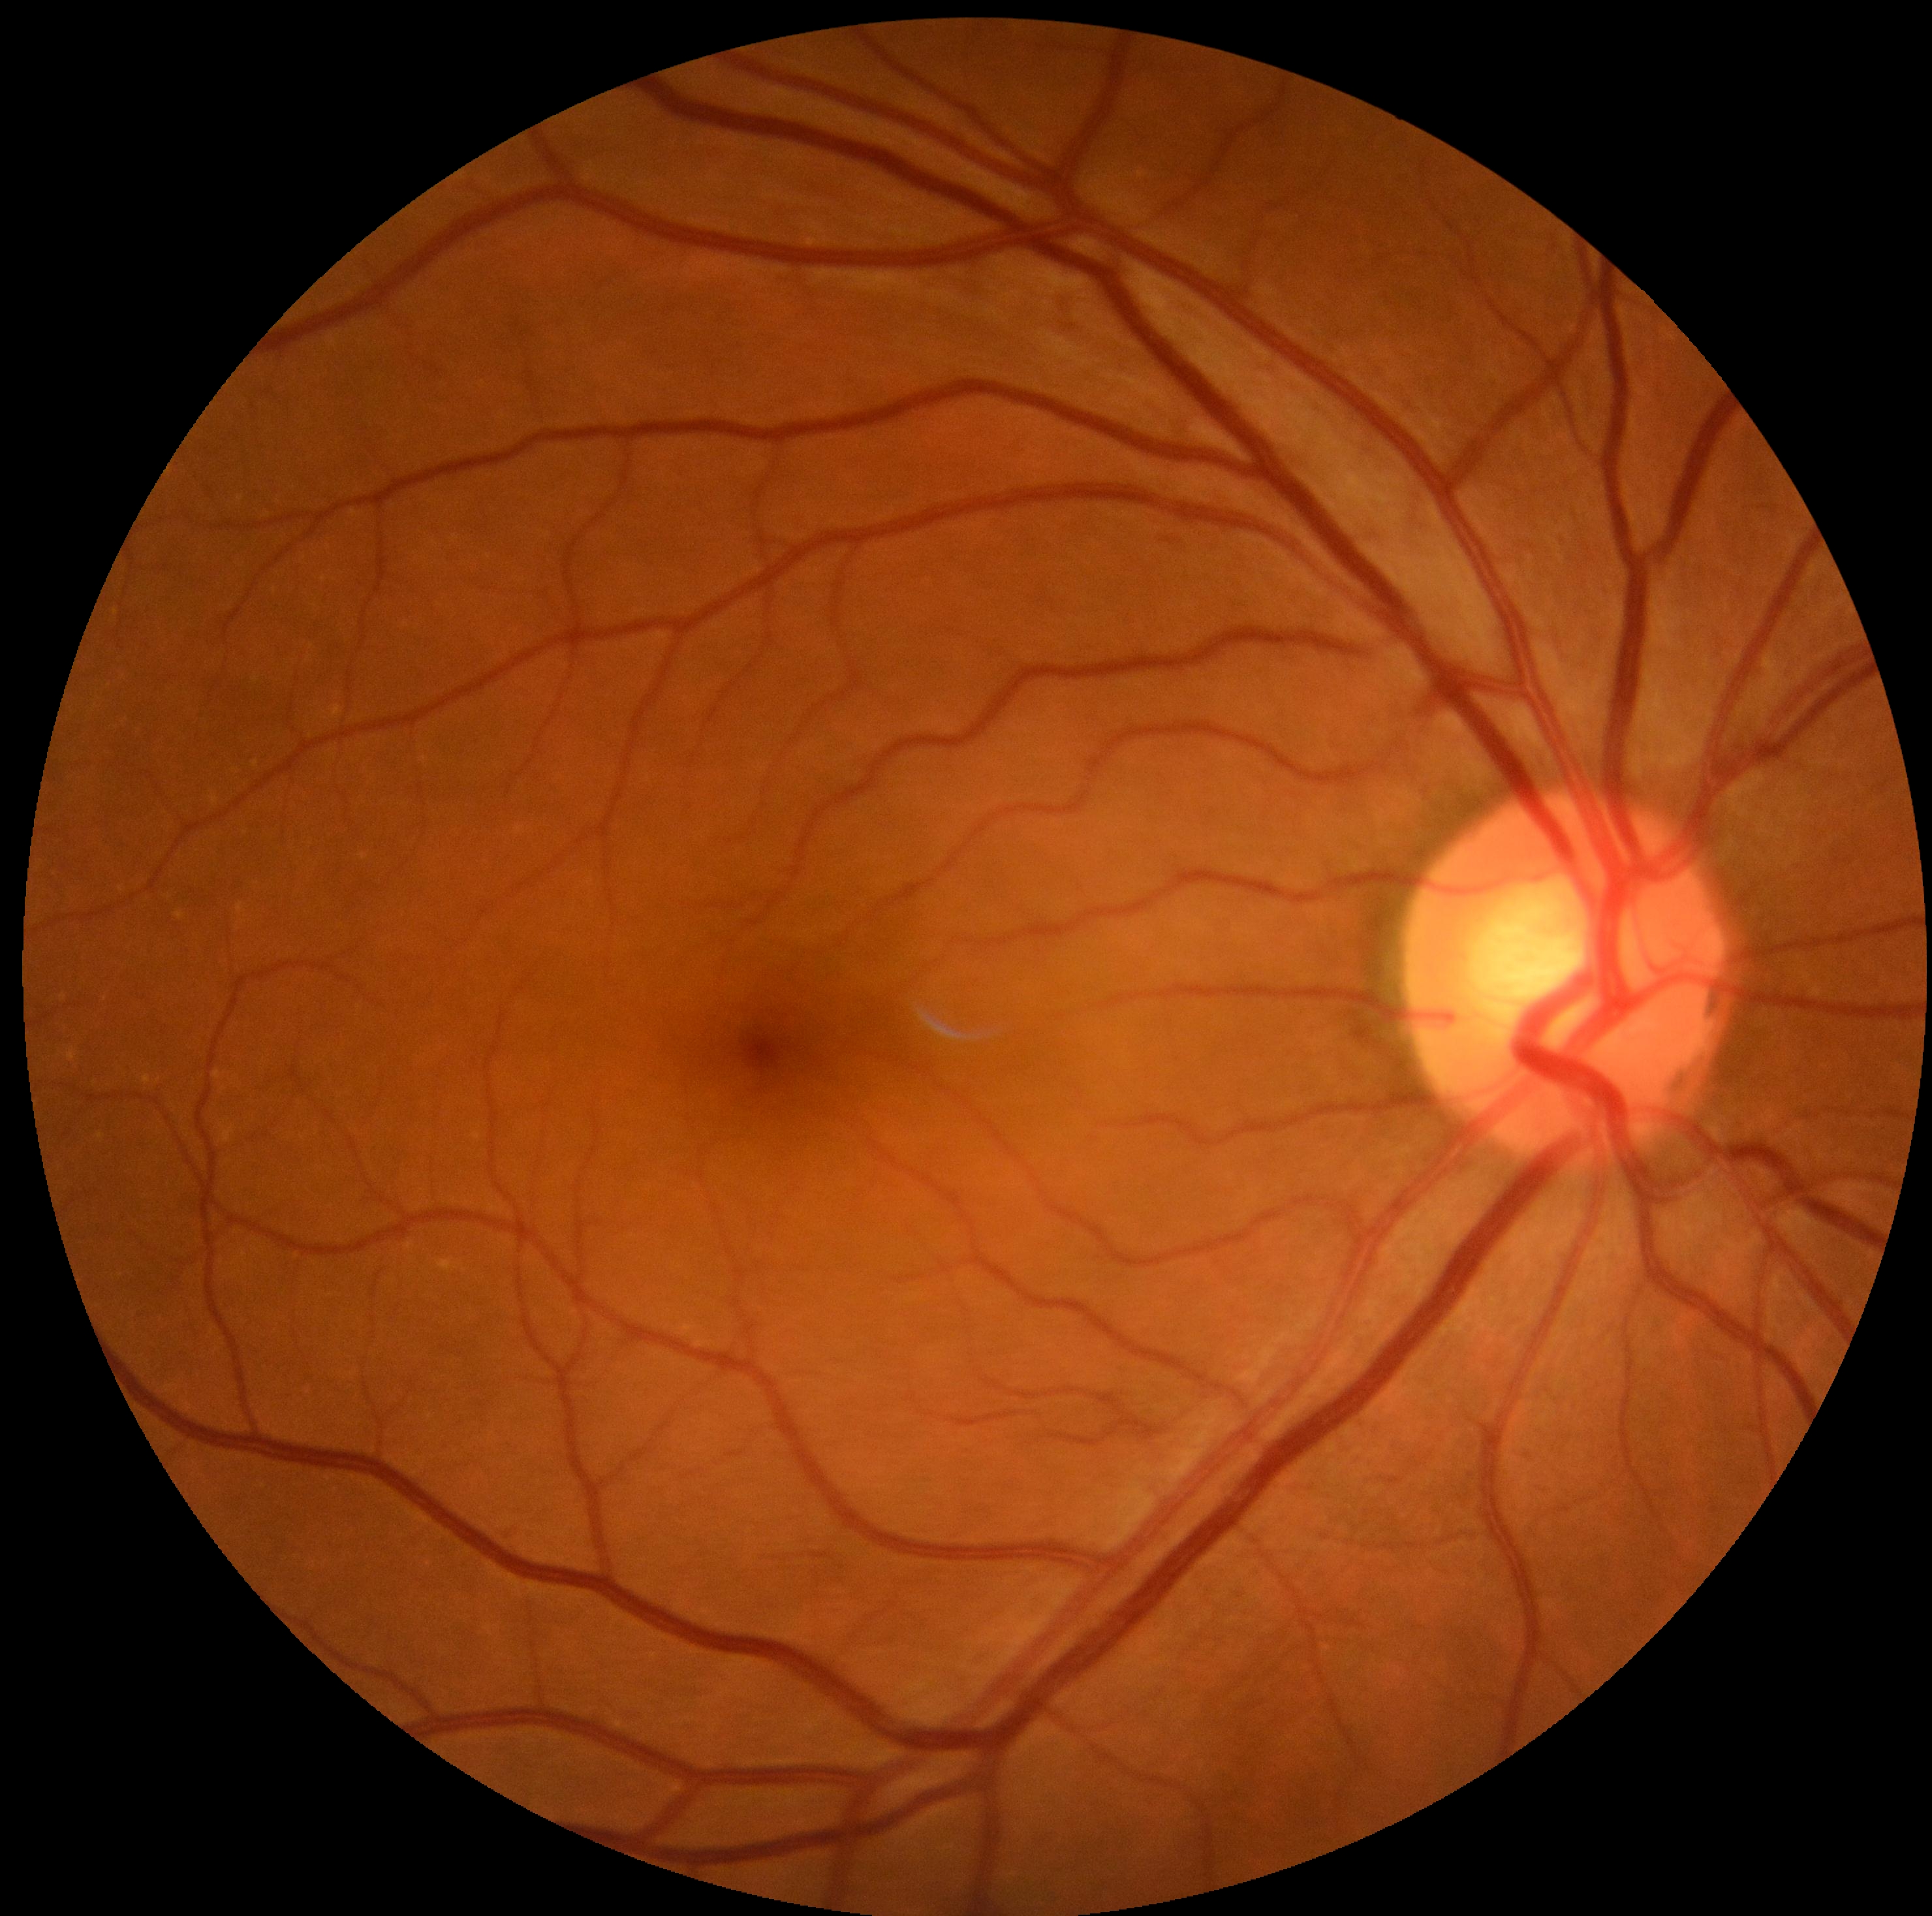

* DR grade: 0 (no apparent retinopathy)